Retinal fundus photograph · 512x512px.
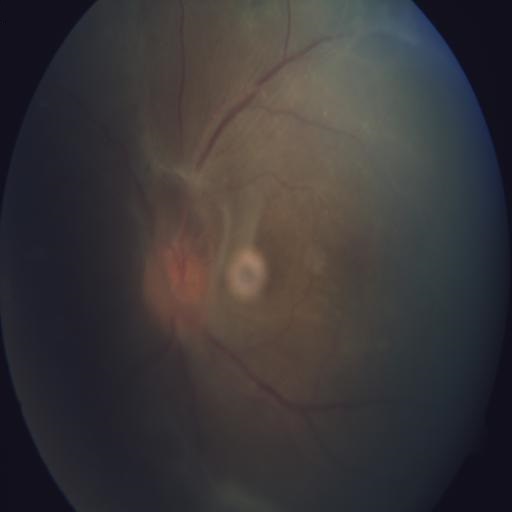 Pathology:
- retinal traction